Wide-field retinal mosaic image — 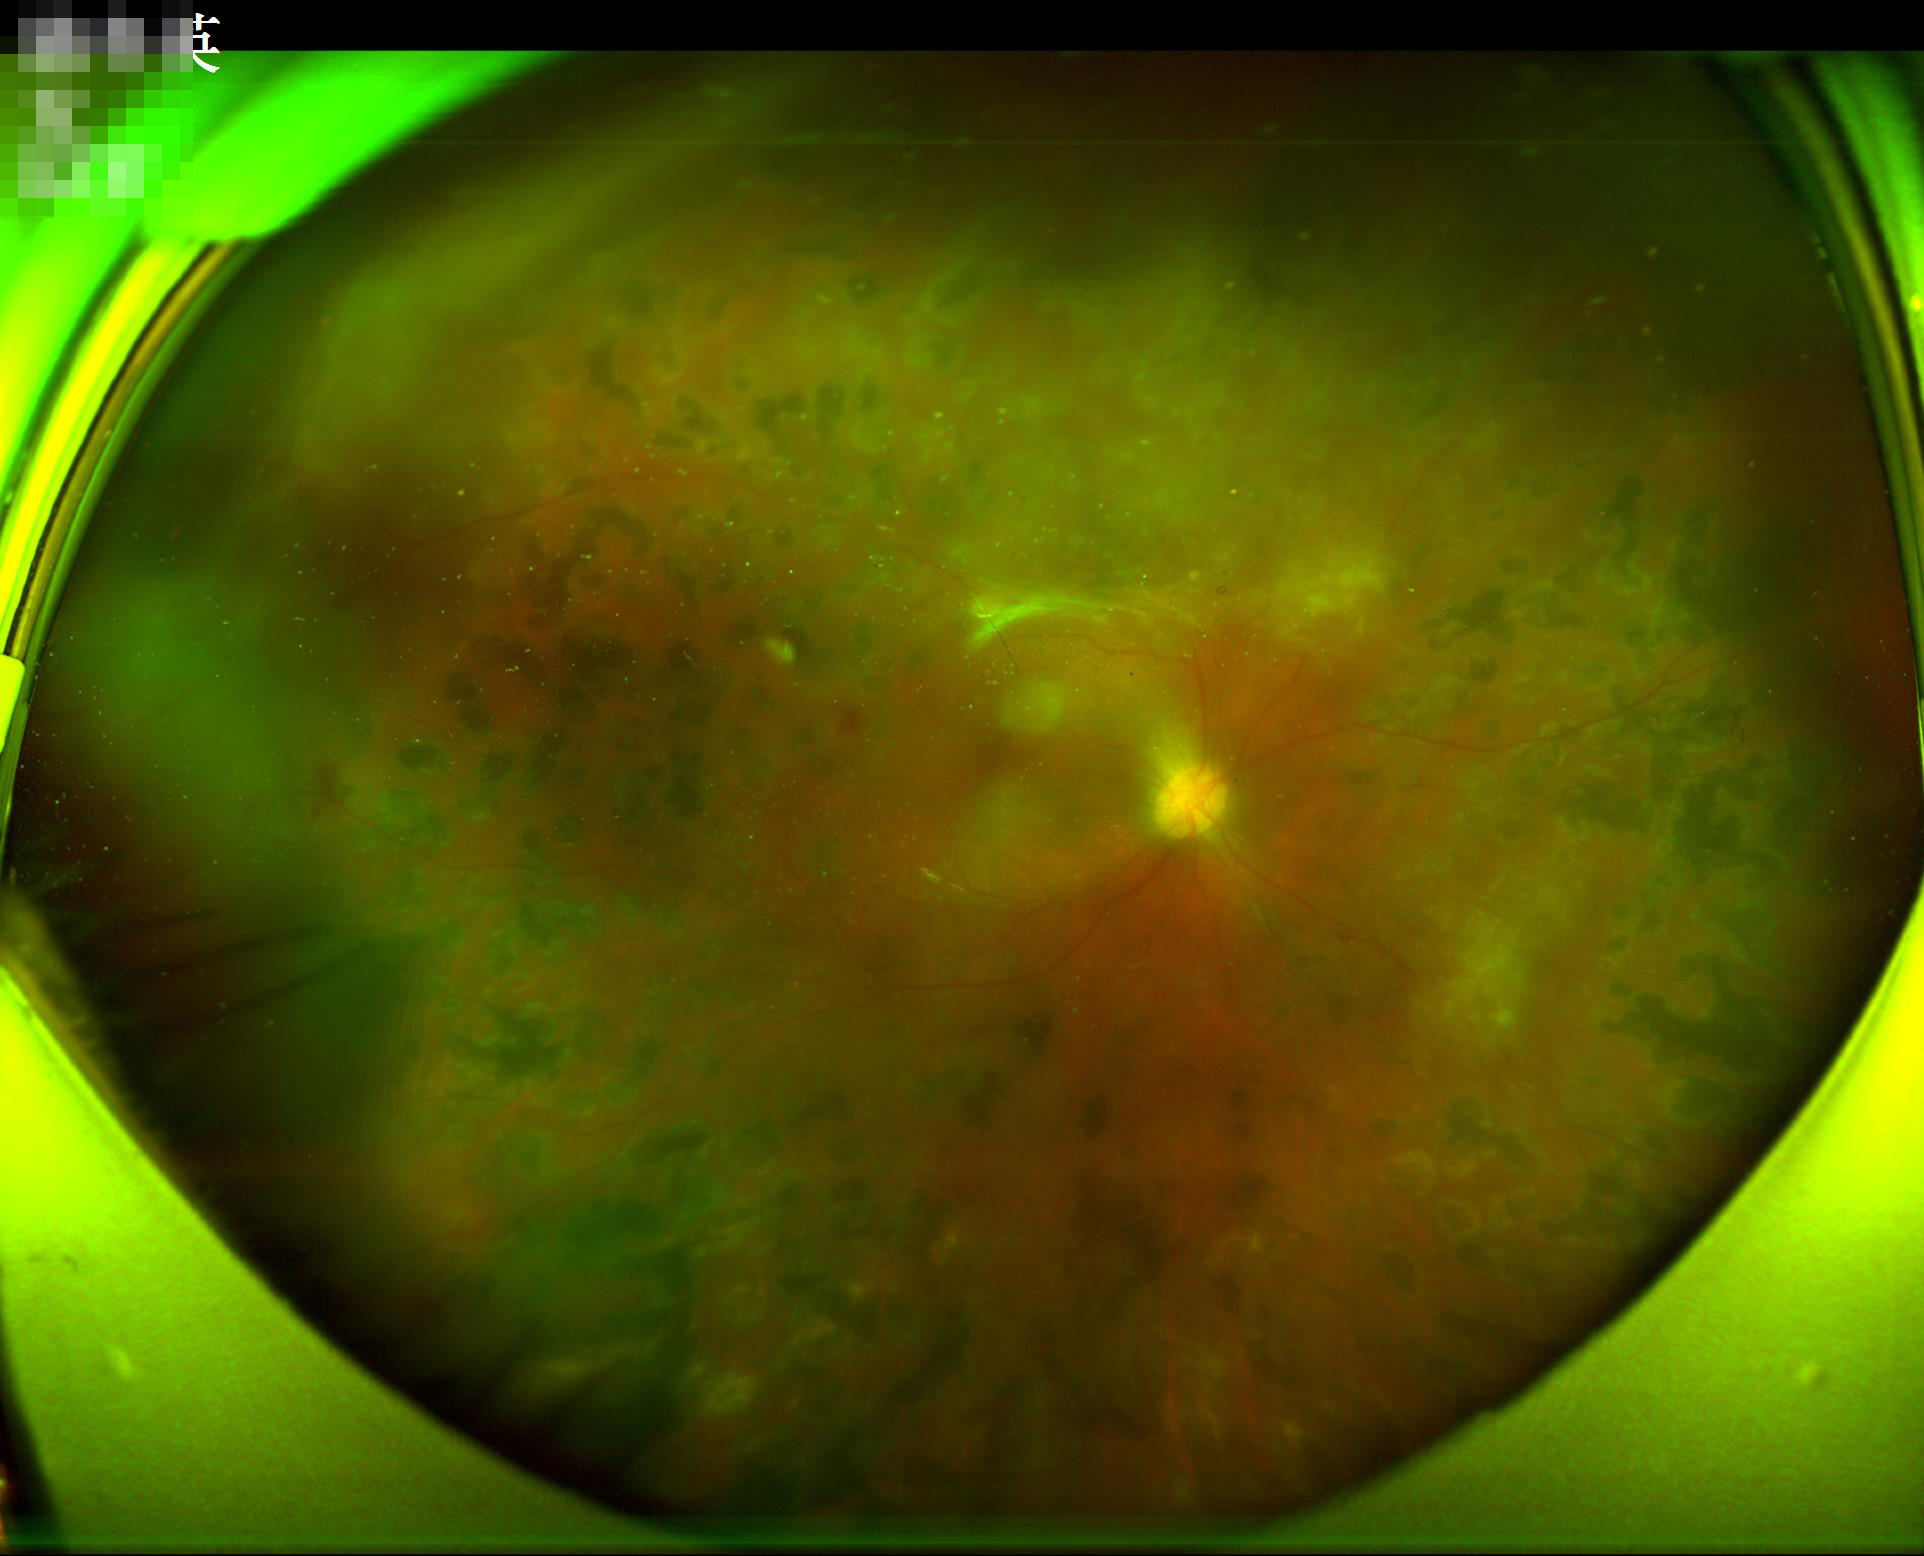

There is over- or under-exposure or a color cast. Adequate contrast for distinguishing structures. Image quality is inadequate for diagnostic use.